640x480; camera: Clarity RetCam 3 (130° FOV); wide-field fundus photograph of an infant.
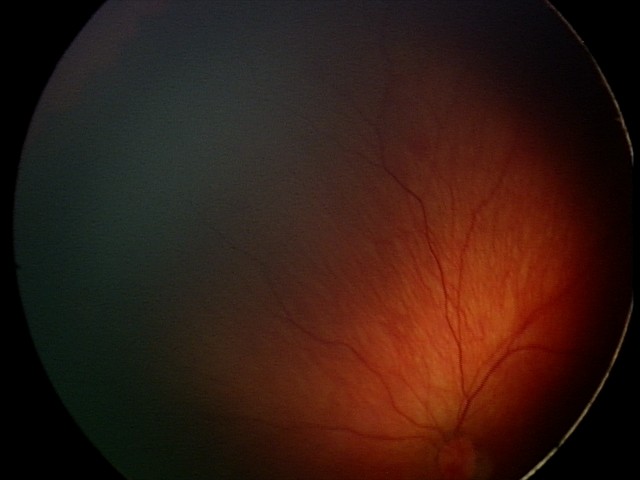

Q: What is the screening diagnosis?
A: retinal hemorrhages